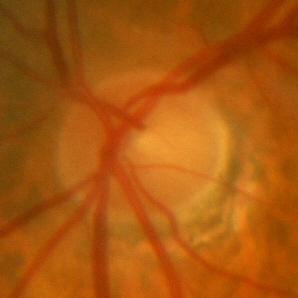 No glaucoma.